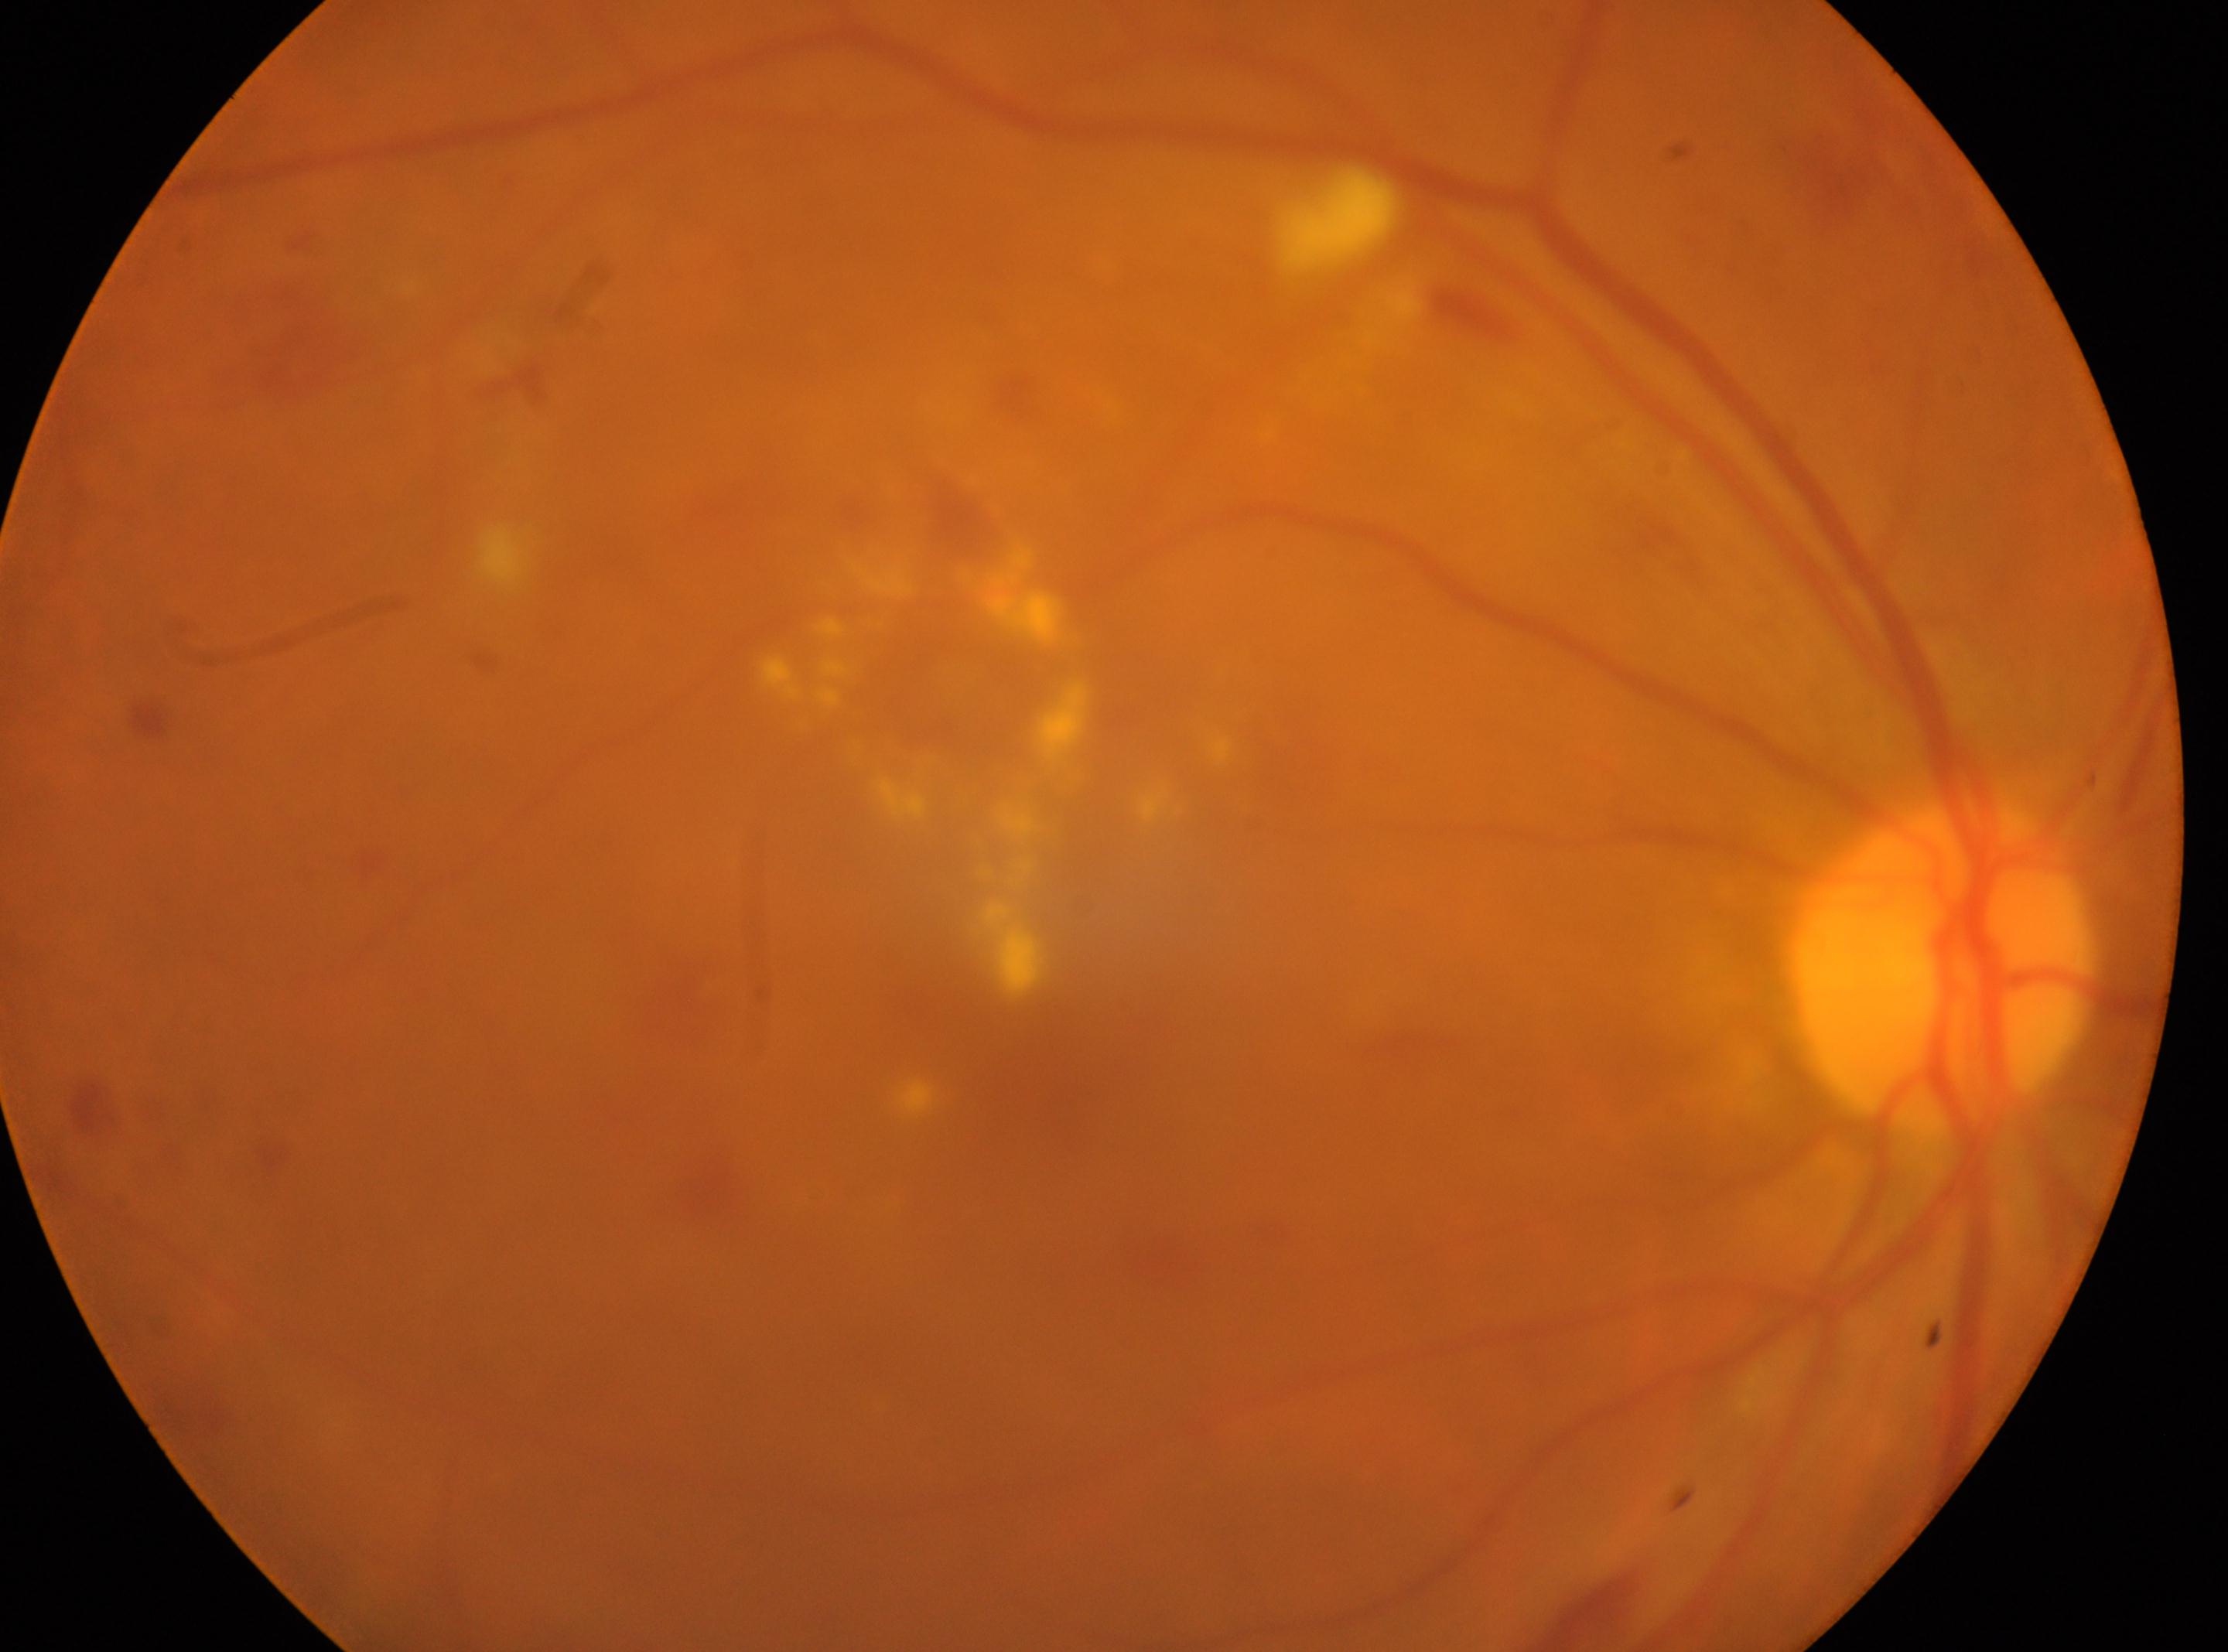 Optic nerve head: (x=1942, y=964). Foveal center located at (x=1029, y=1063). Eye: oculus dexter. Retinopathy is grade 2.